848x848; acquired with a NIDEK AFC-230 — 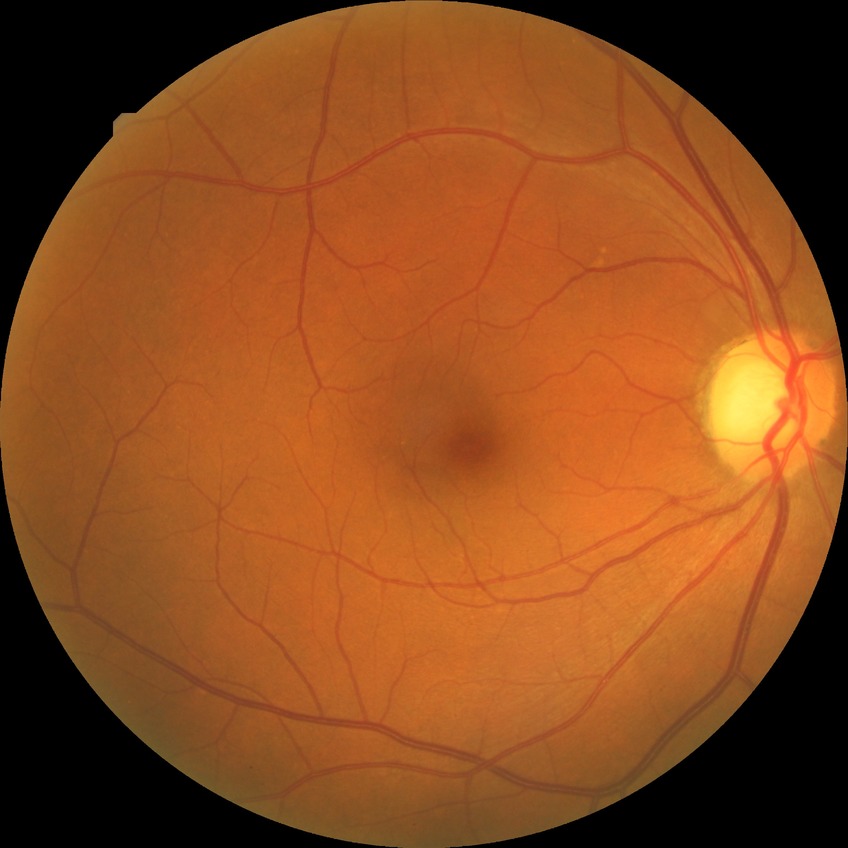 Diabetic retinopathy grade is no diabetic retinopathy.